Fundus photo; 2352x1568:
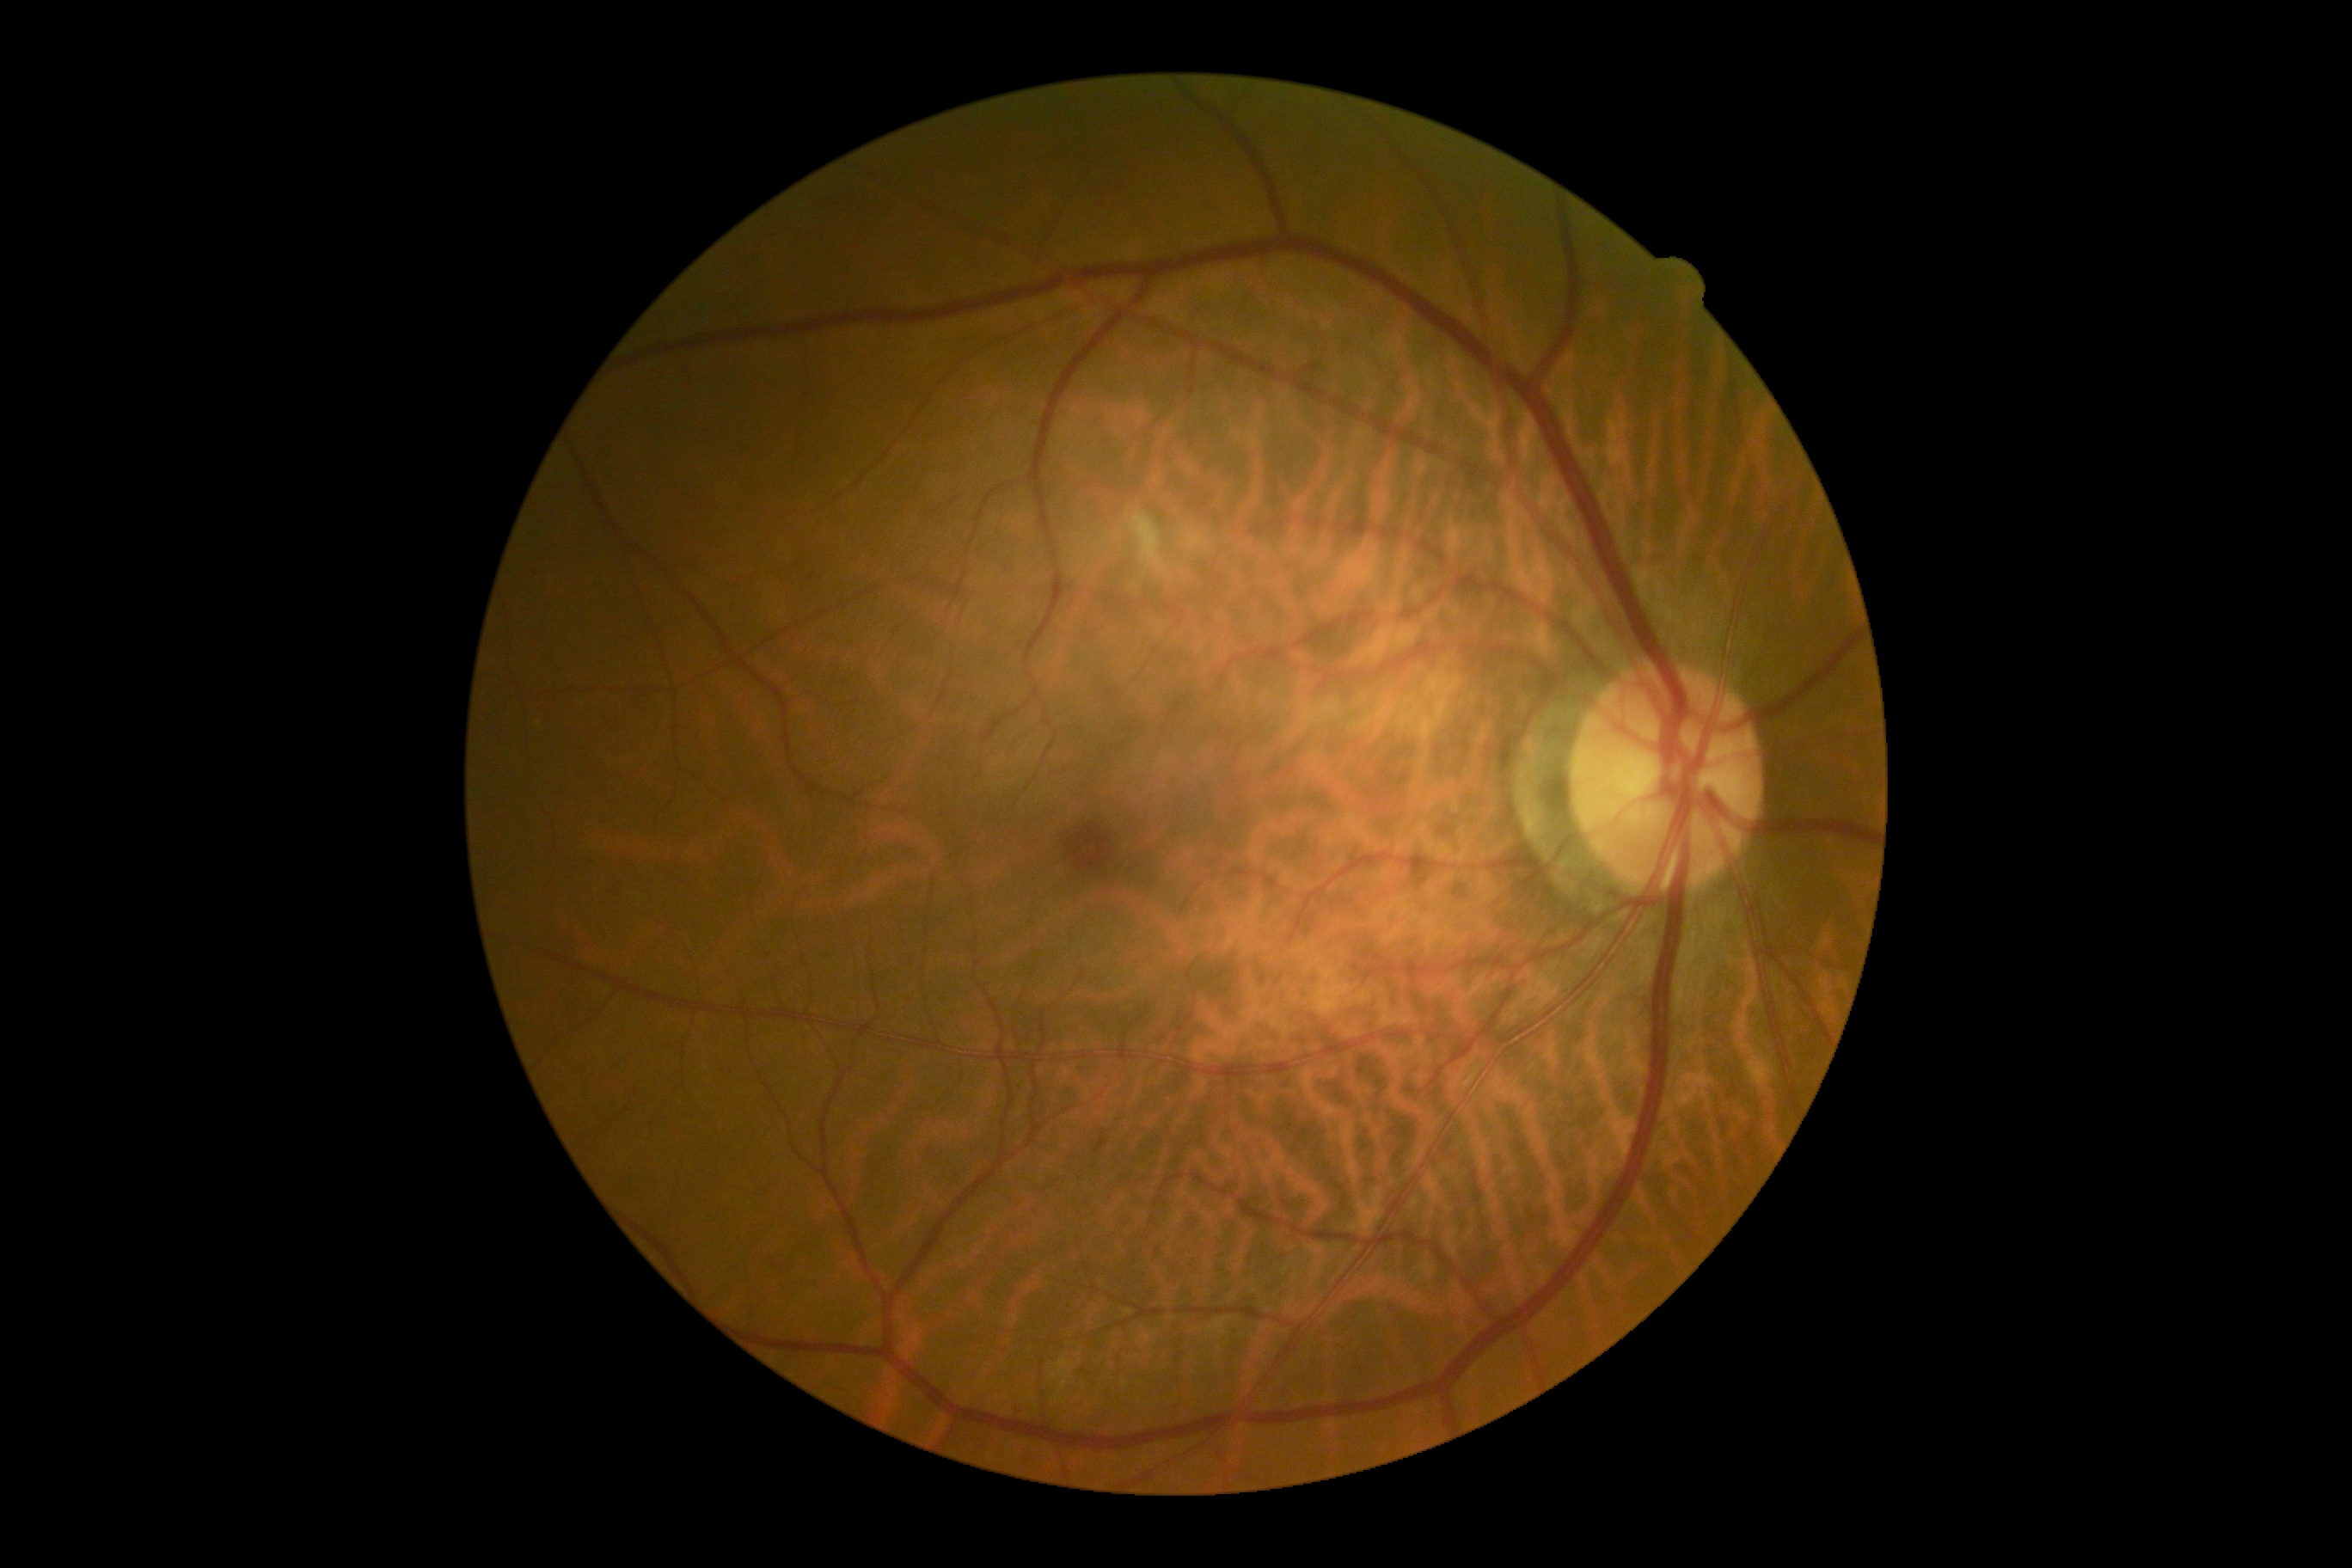 DR class = non-proliferative diabetic retinopathy
DR = moderate non-proliferative diabetic retinopathy (grade 2)